Acquired on the Phoenix ICON · wide-field fundus image from infant ROP screening · 1240x1240px
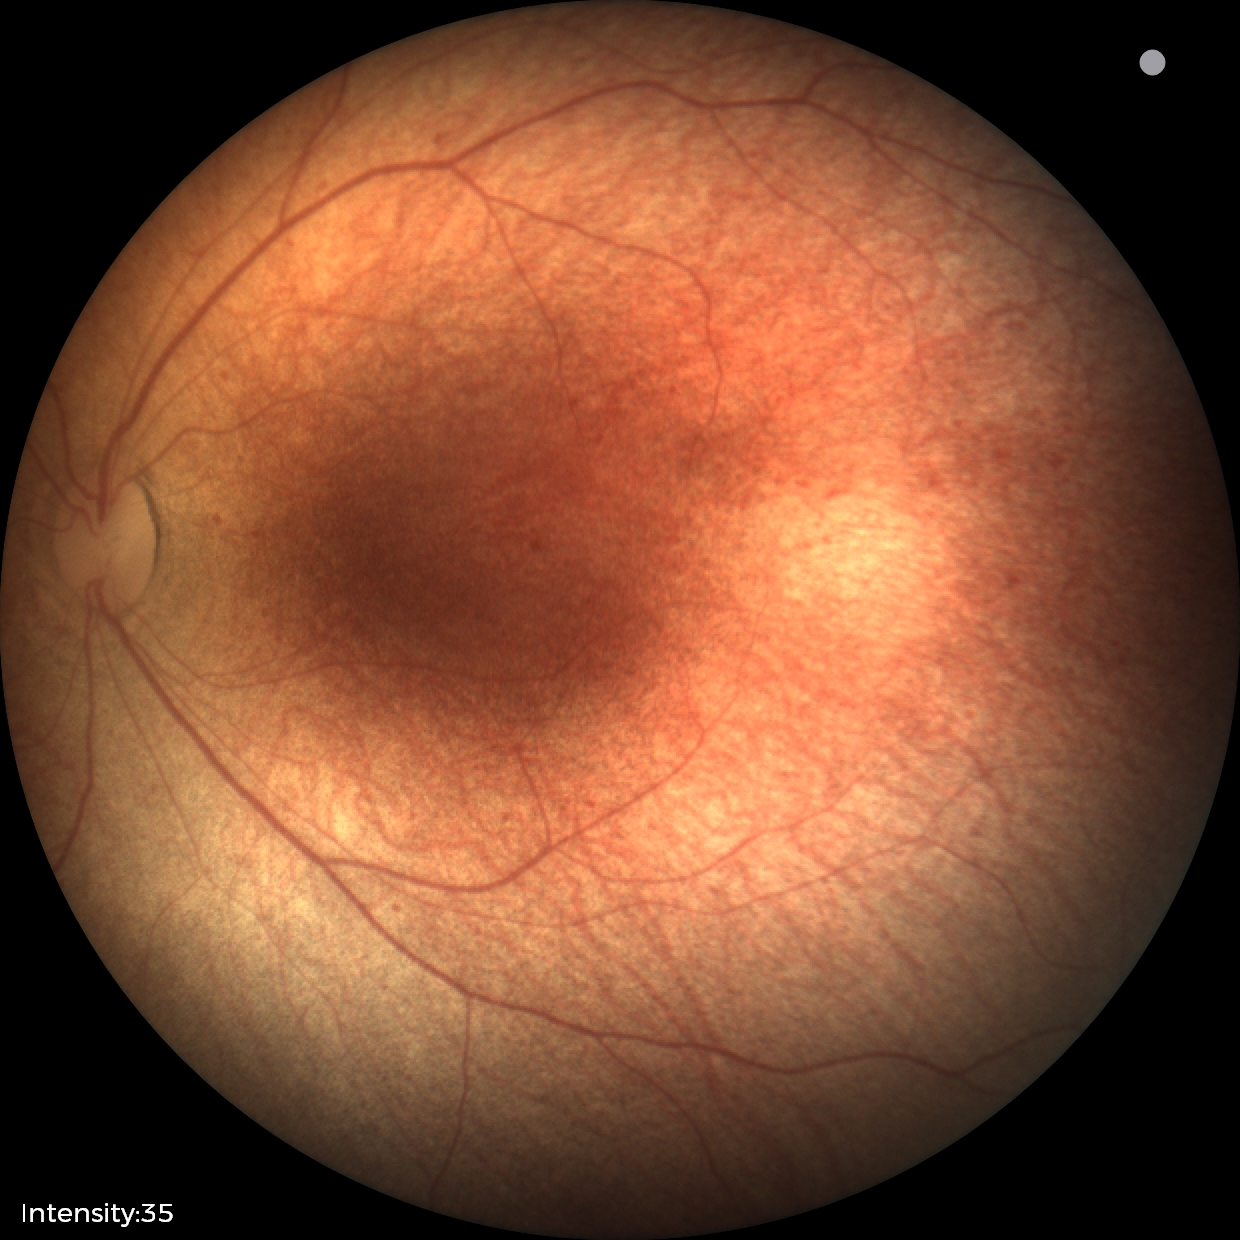 No retinal pathology identified on screening.